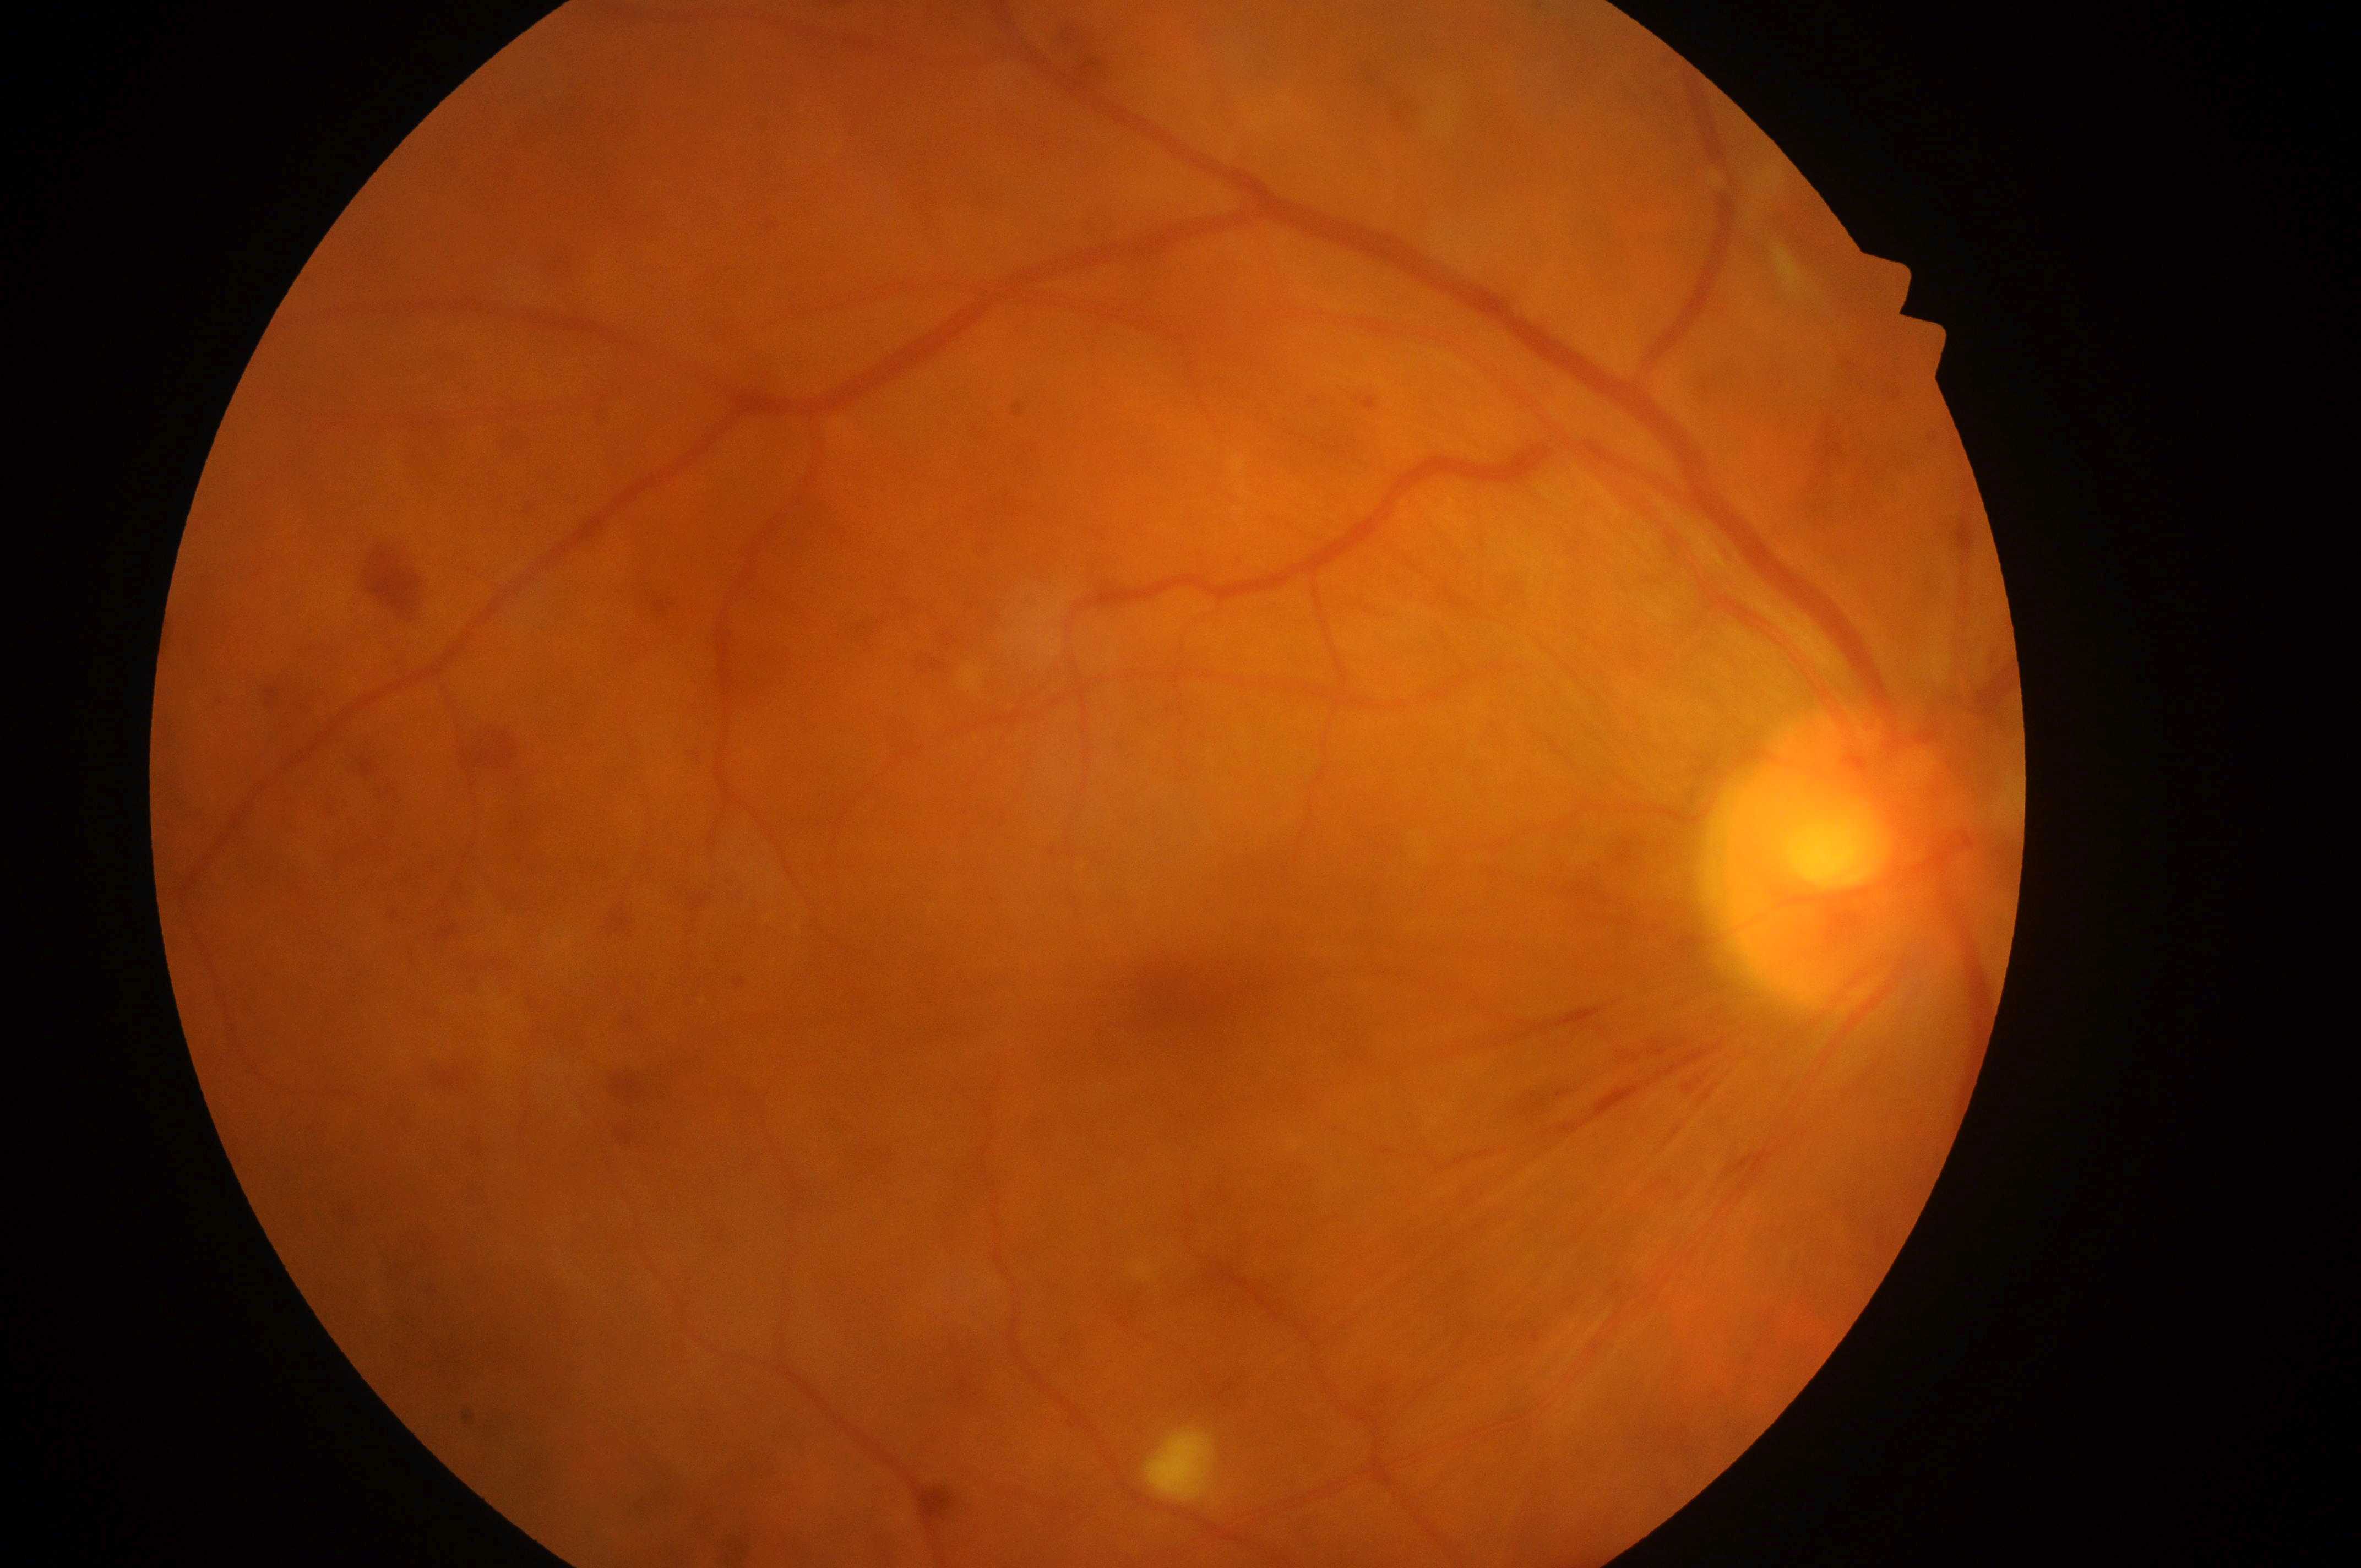 Optic nerve head: (x: 1826, y: 868). Macular edema is grade 2. Diabetic retinopathy grade: 4/4. Fovea center located at (x: 1190, y: 998). Imaged eye: OD.